Nonmydriatic; image size 848x848; NIDEK AFC-230 fundus camera; posterior pole color fundus photograph; 45 degree fundus photograph.
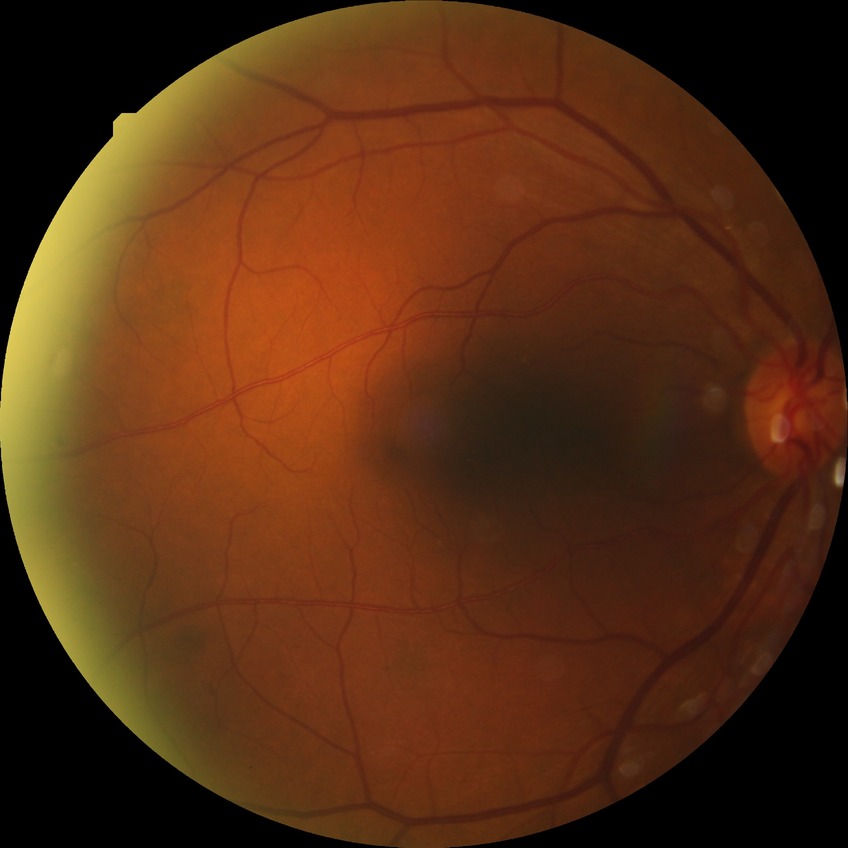

diabetic retinopathy (DR): SDR (simple diabetic retinopathy).